NIDEK AFC-230: 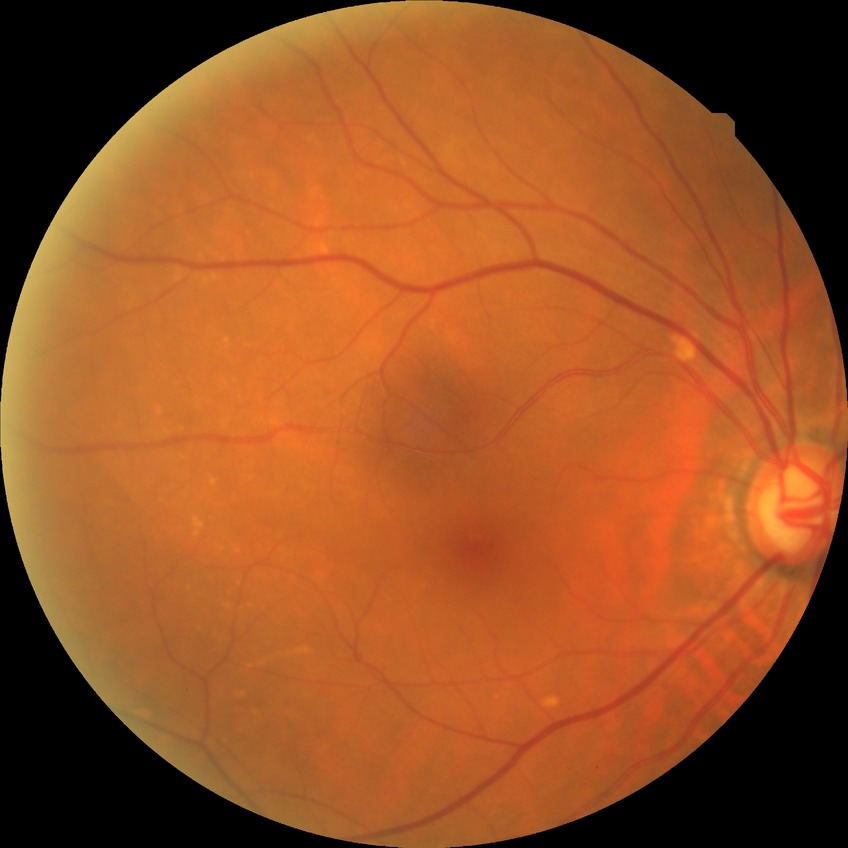

retinopathy grade@no diabetic retinopathy.